45-degree field of view — 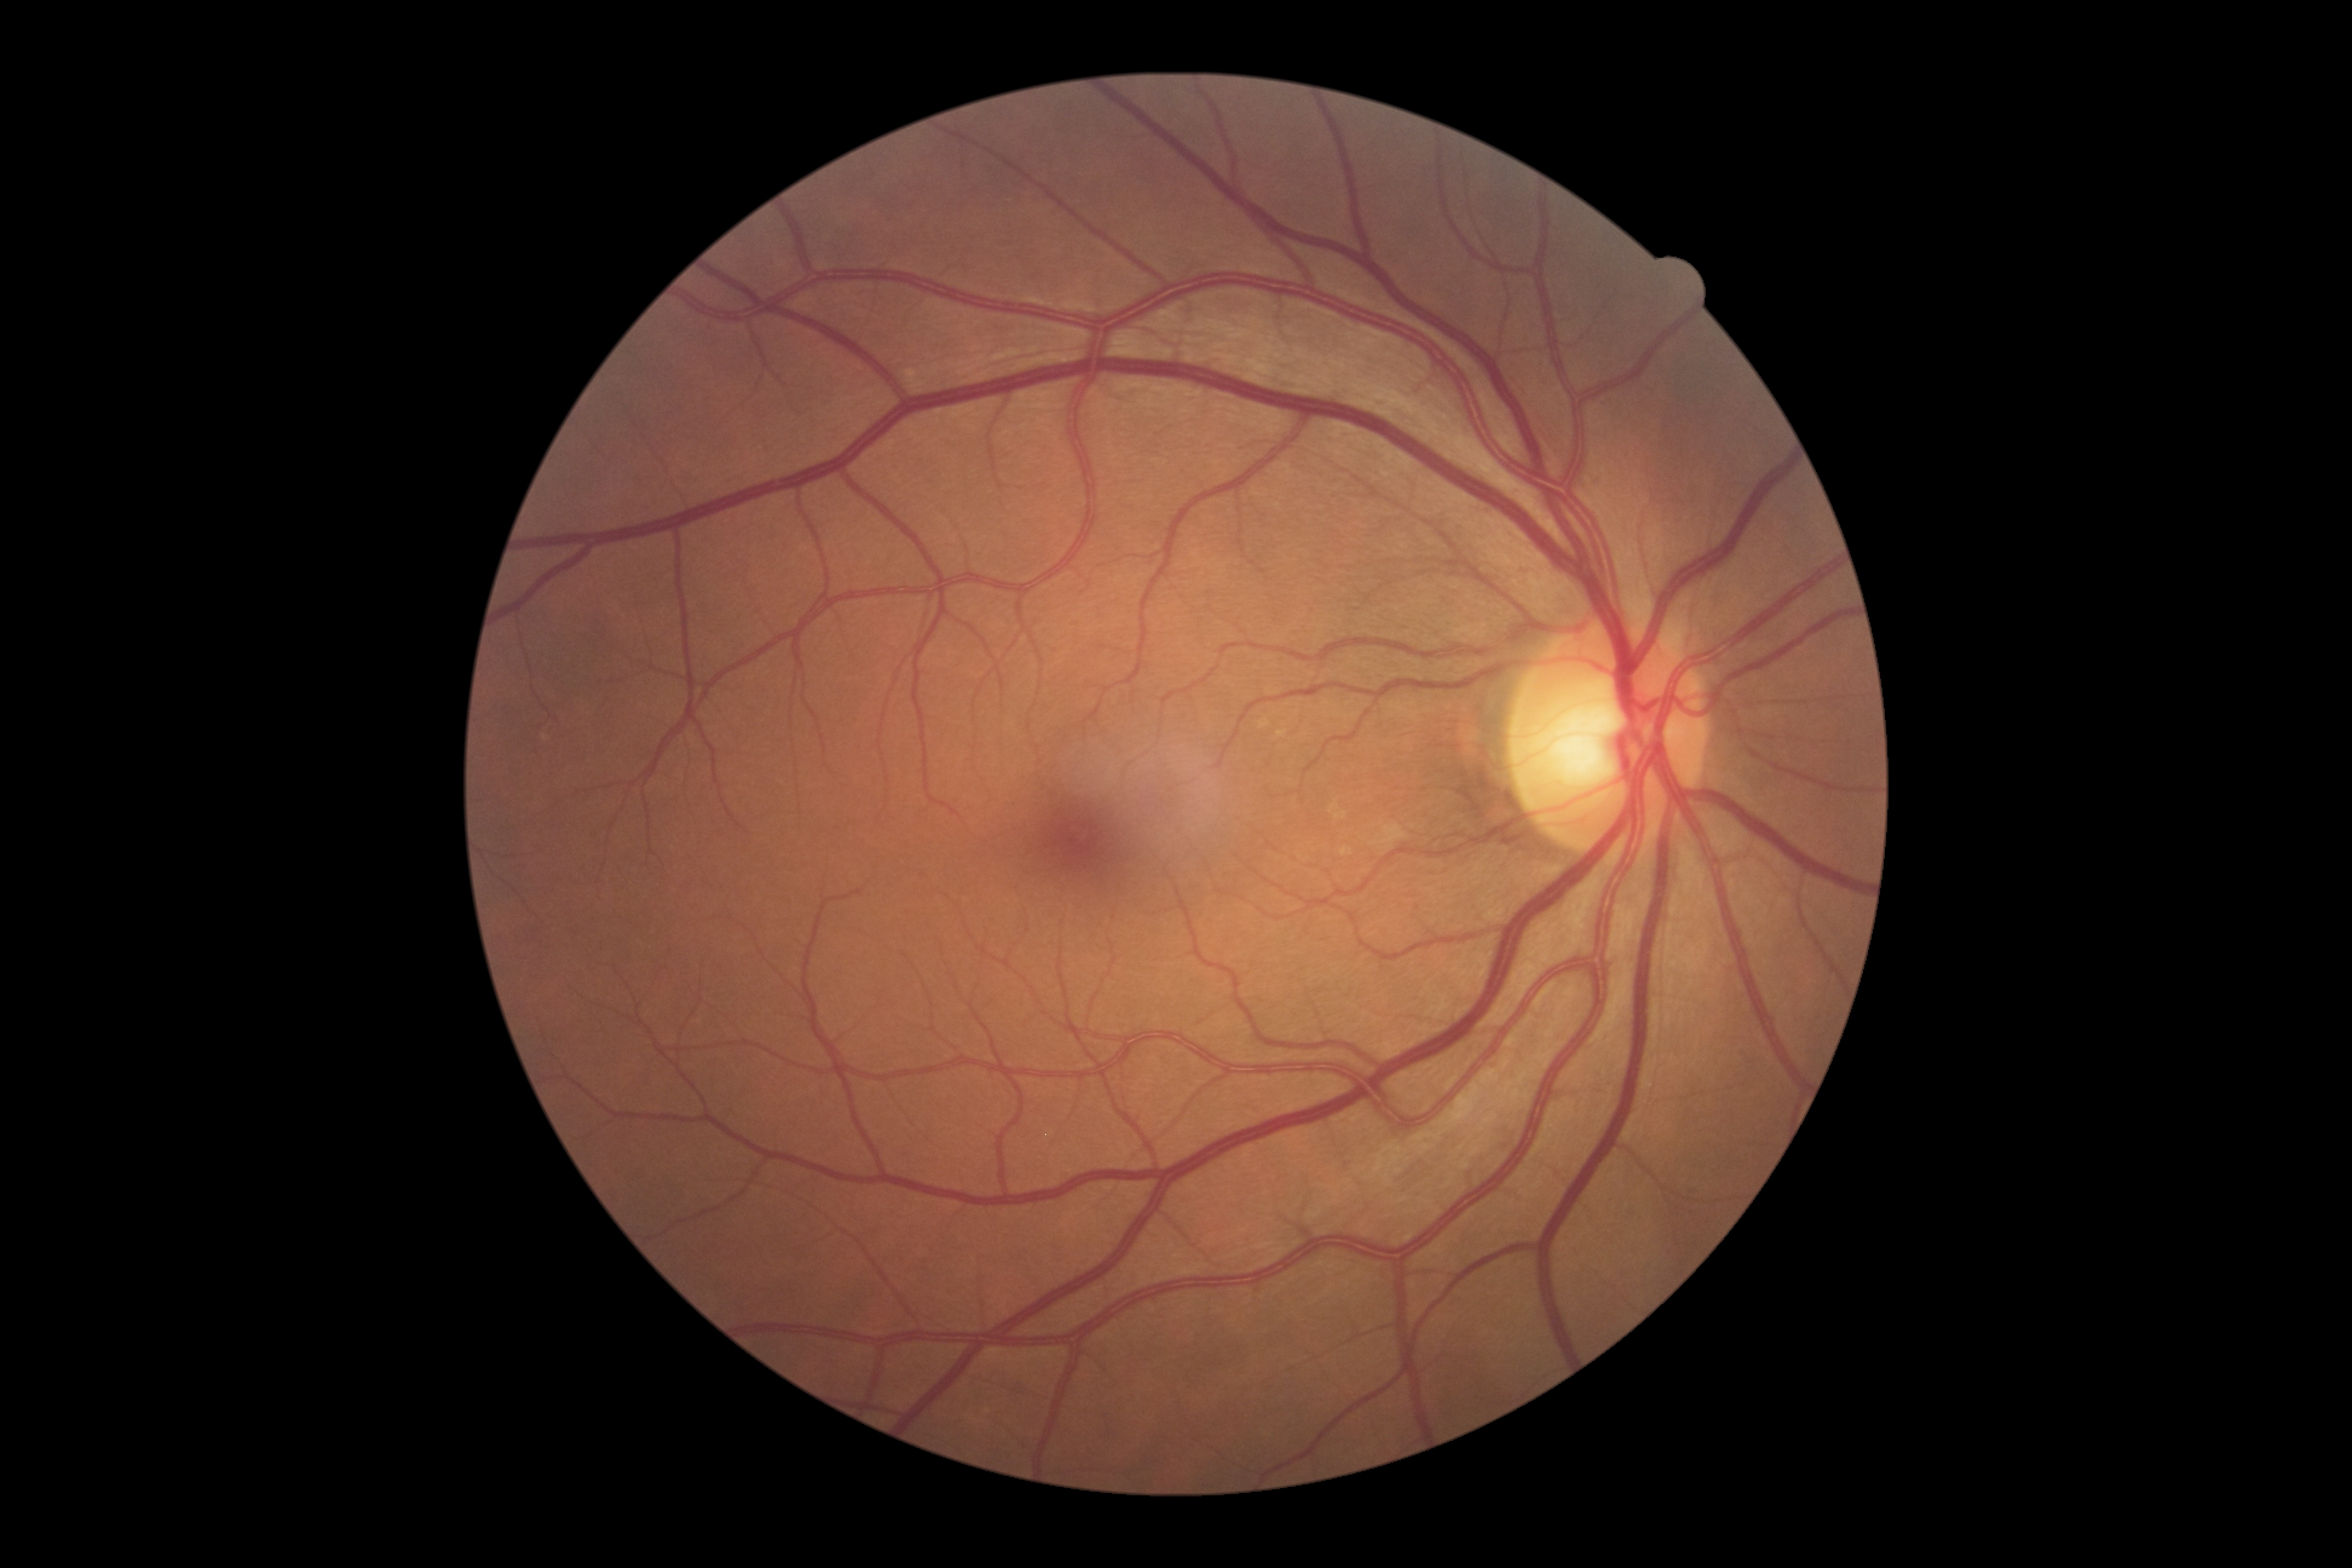

DR: grade 0.